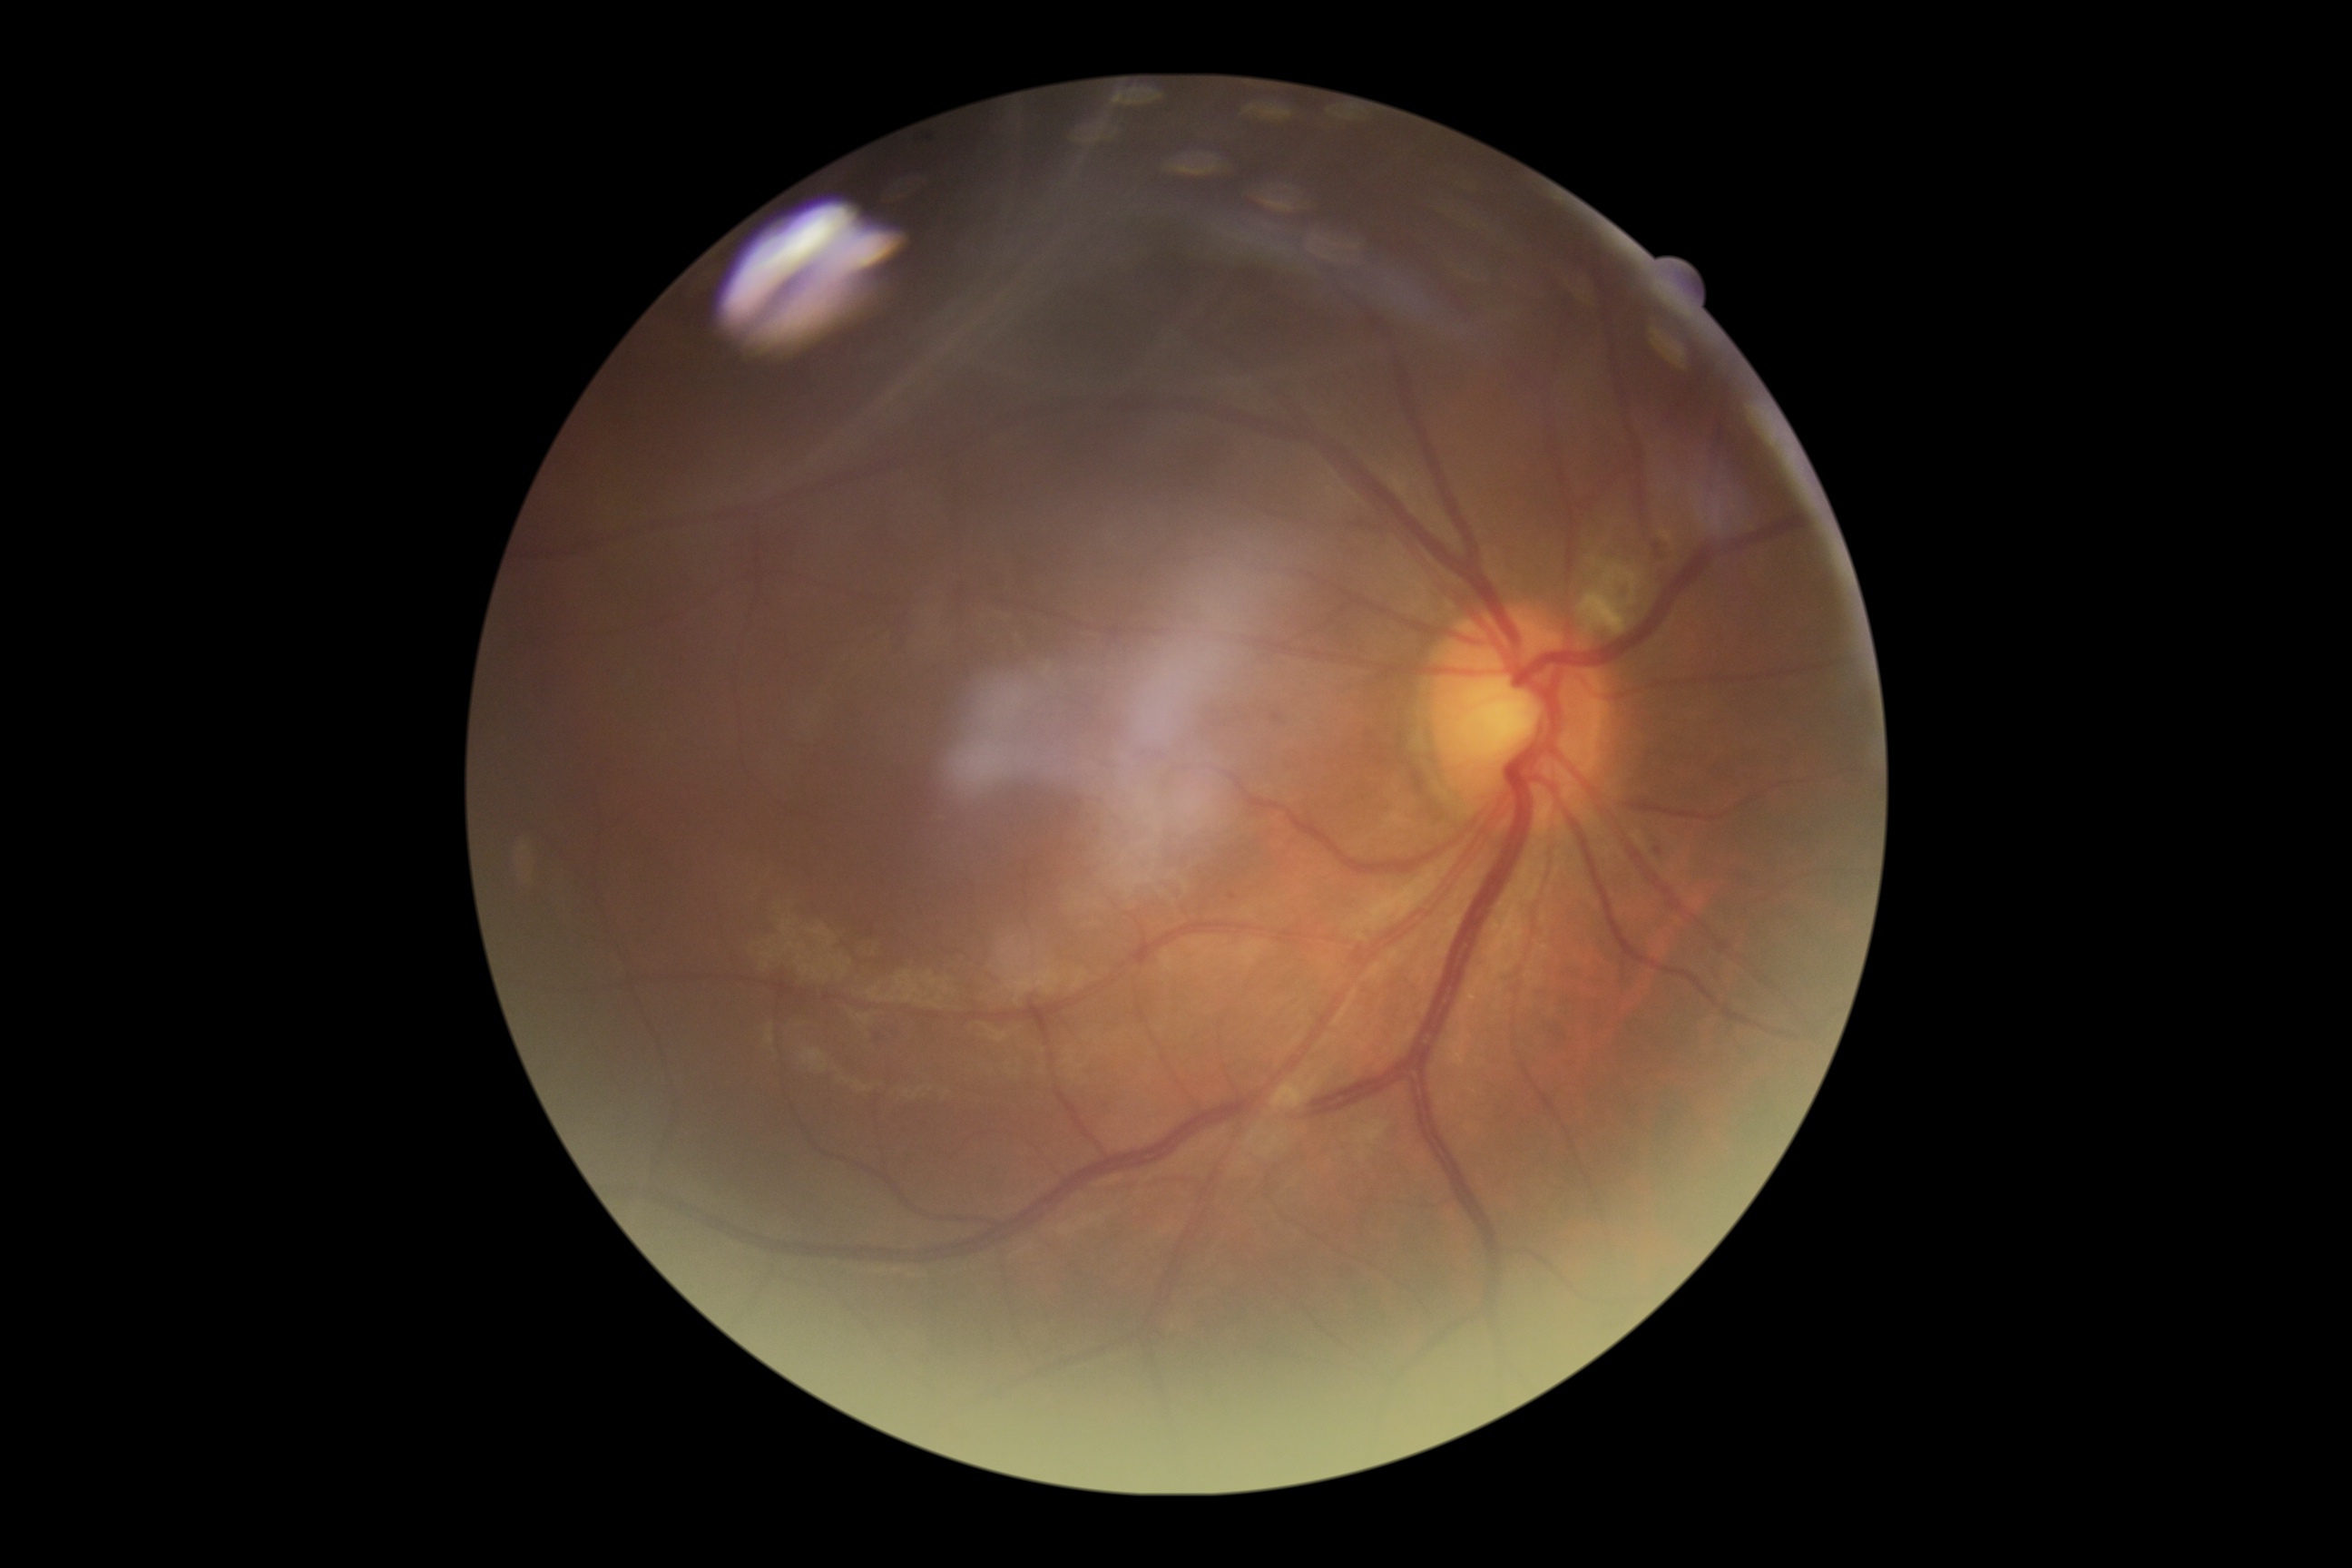
Diabetic retinopathy severity: grade 2 (moderate NPDR) — more than just microaneurysms but less than severe NPDR. DR class: non-proliferative diabetic retinopathy.